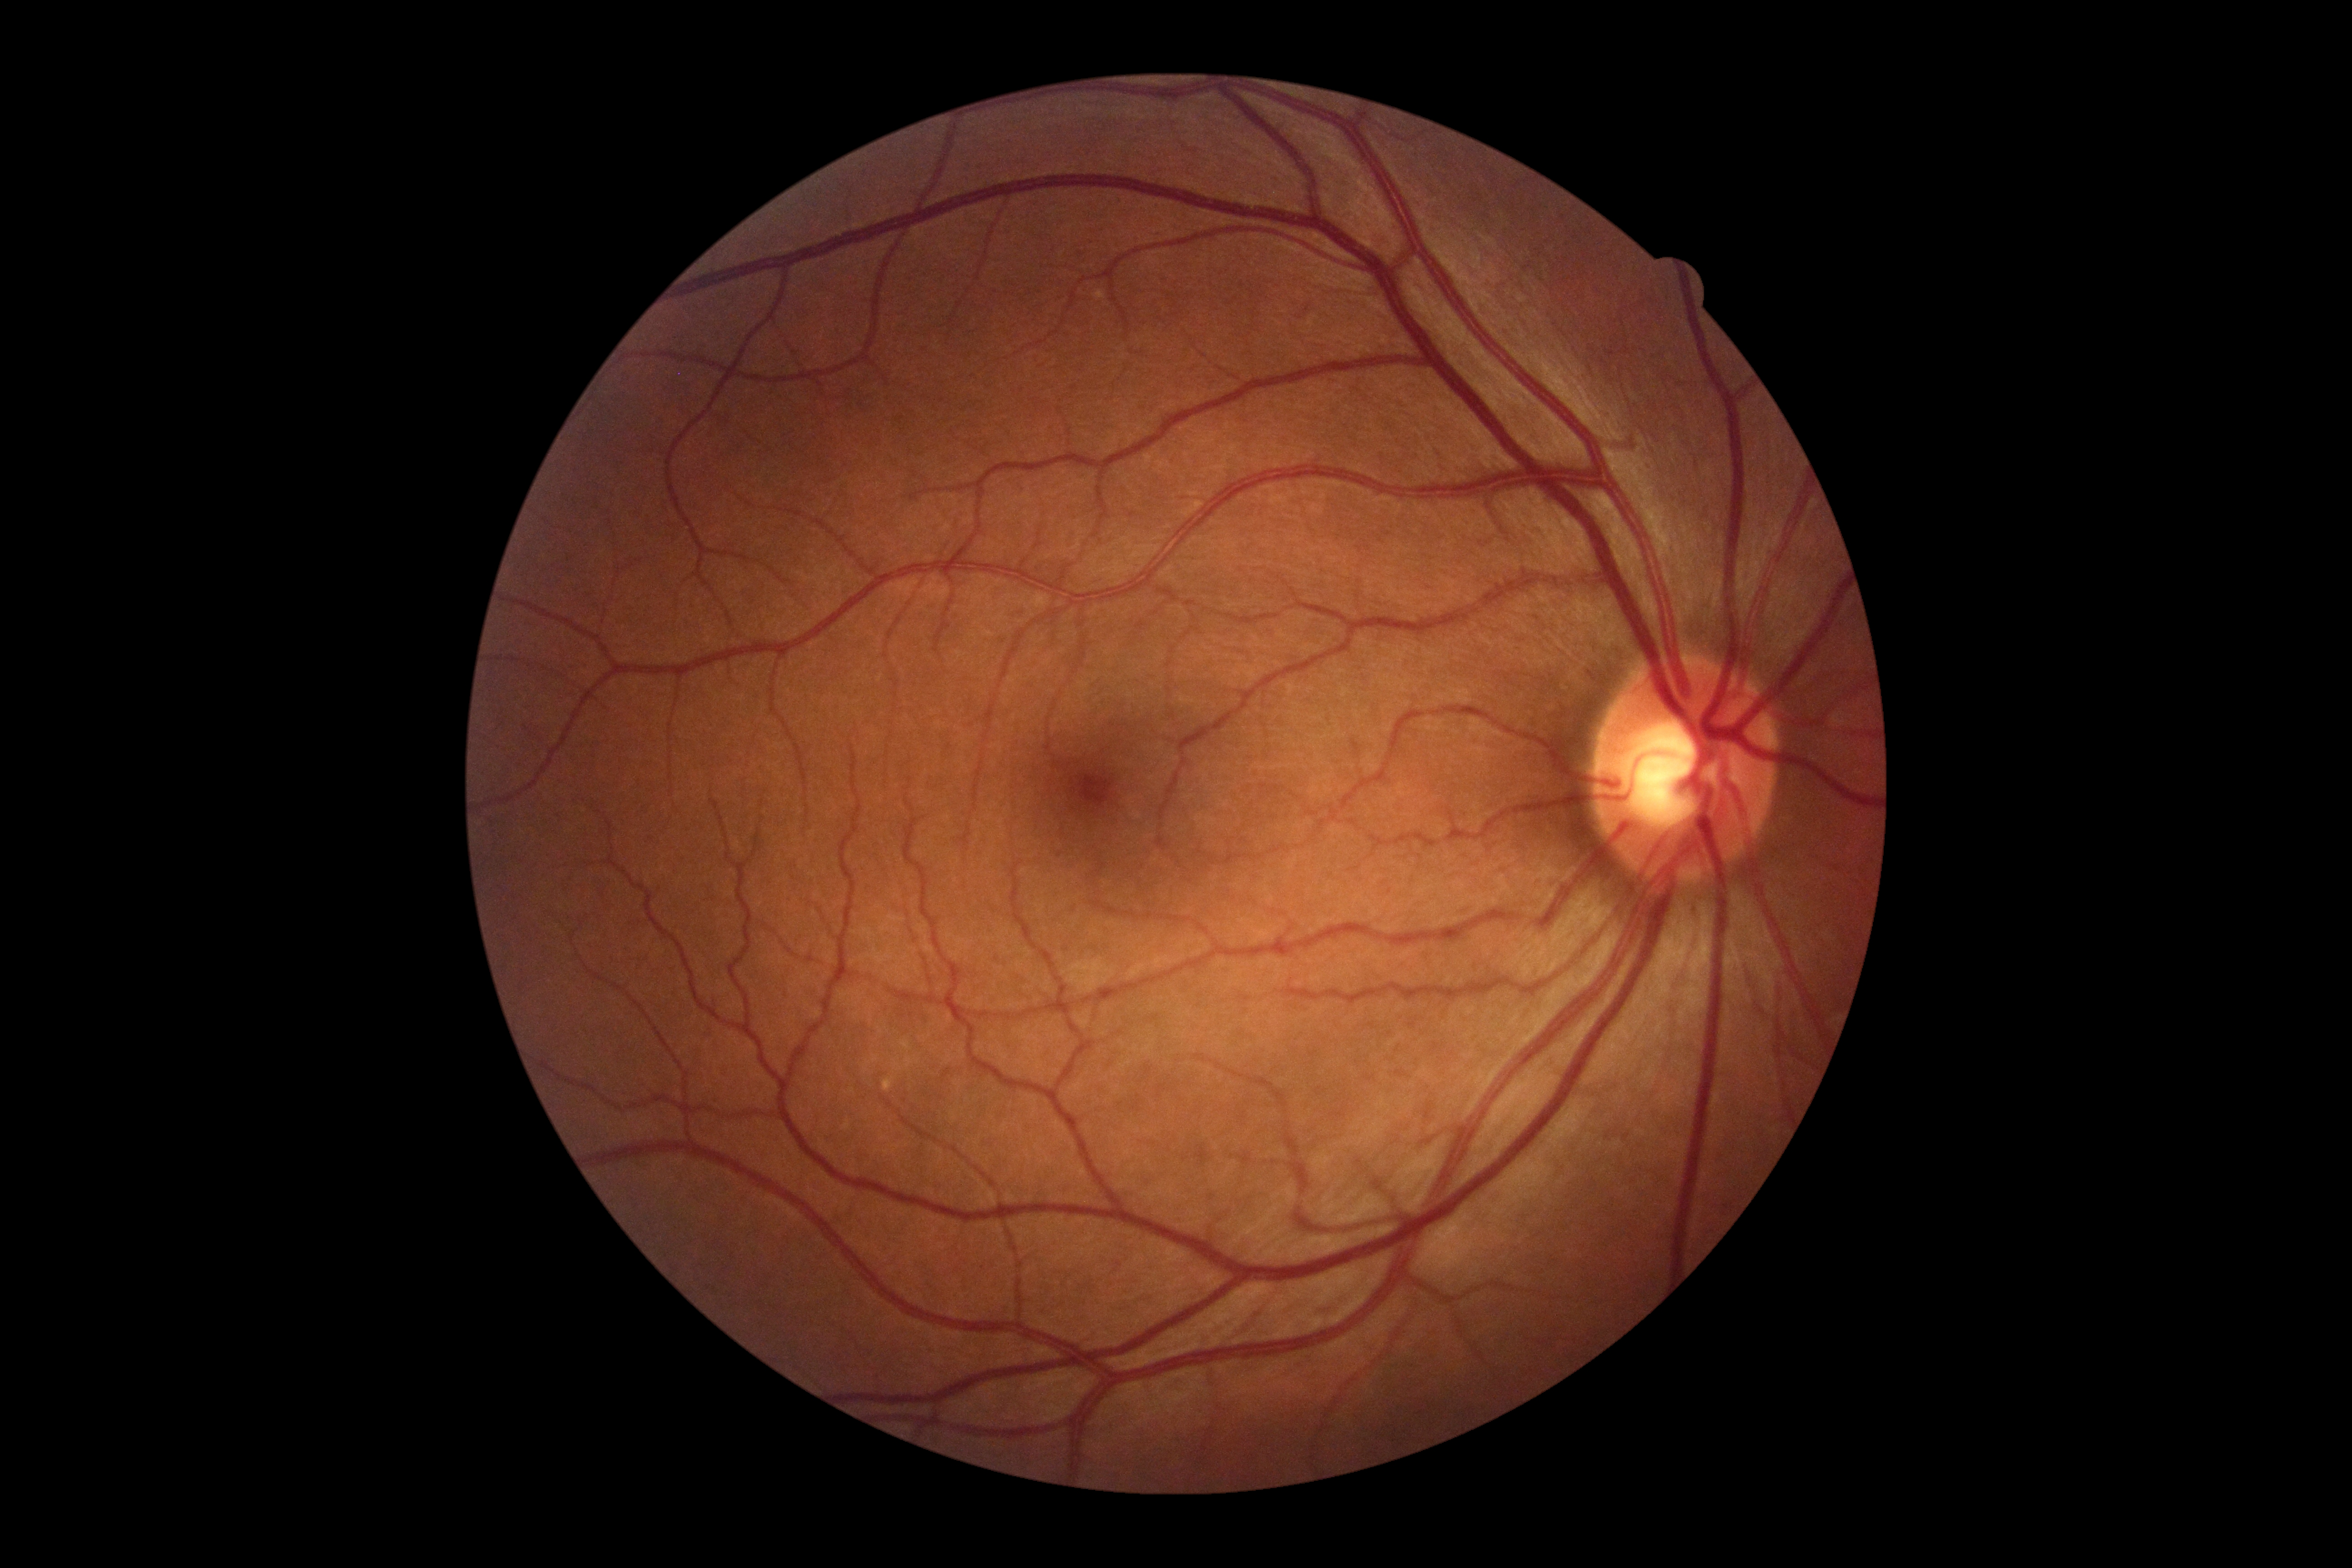
DR is 0/4.